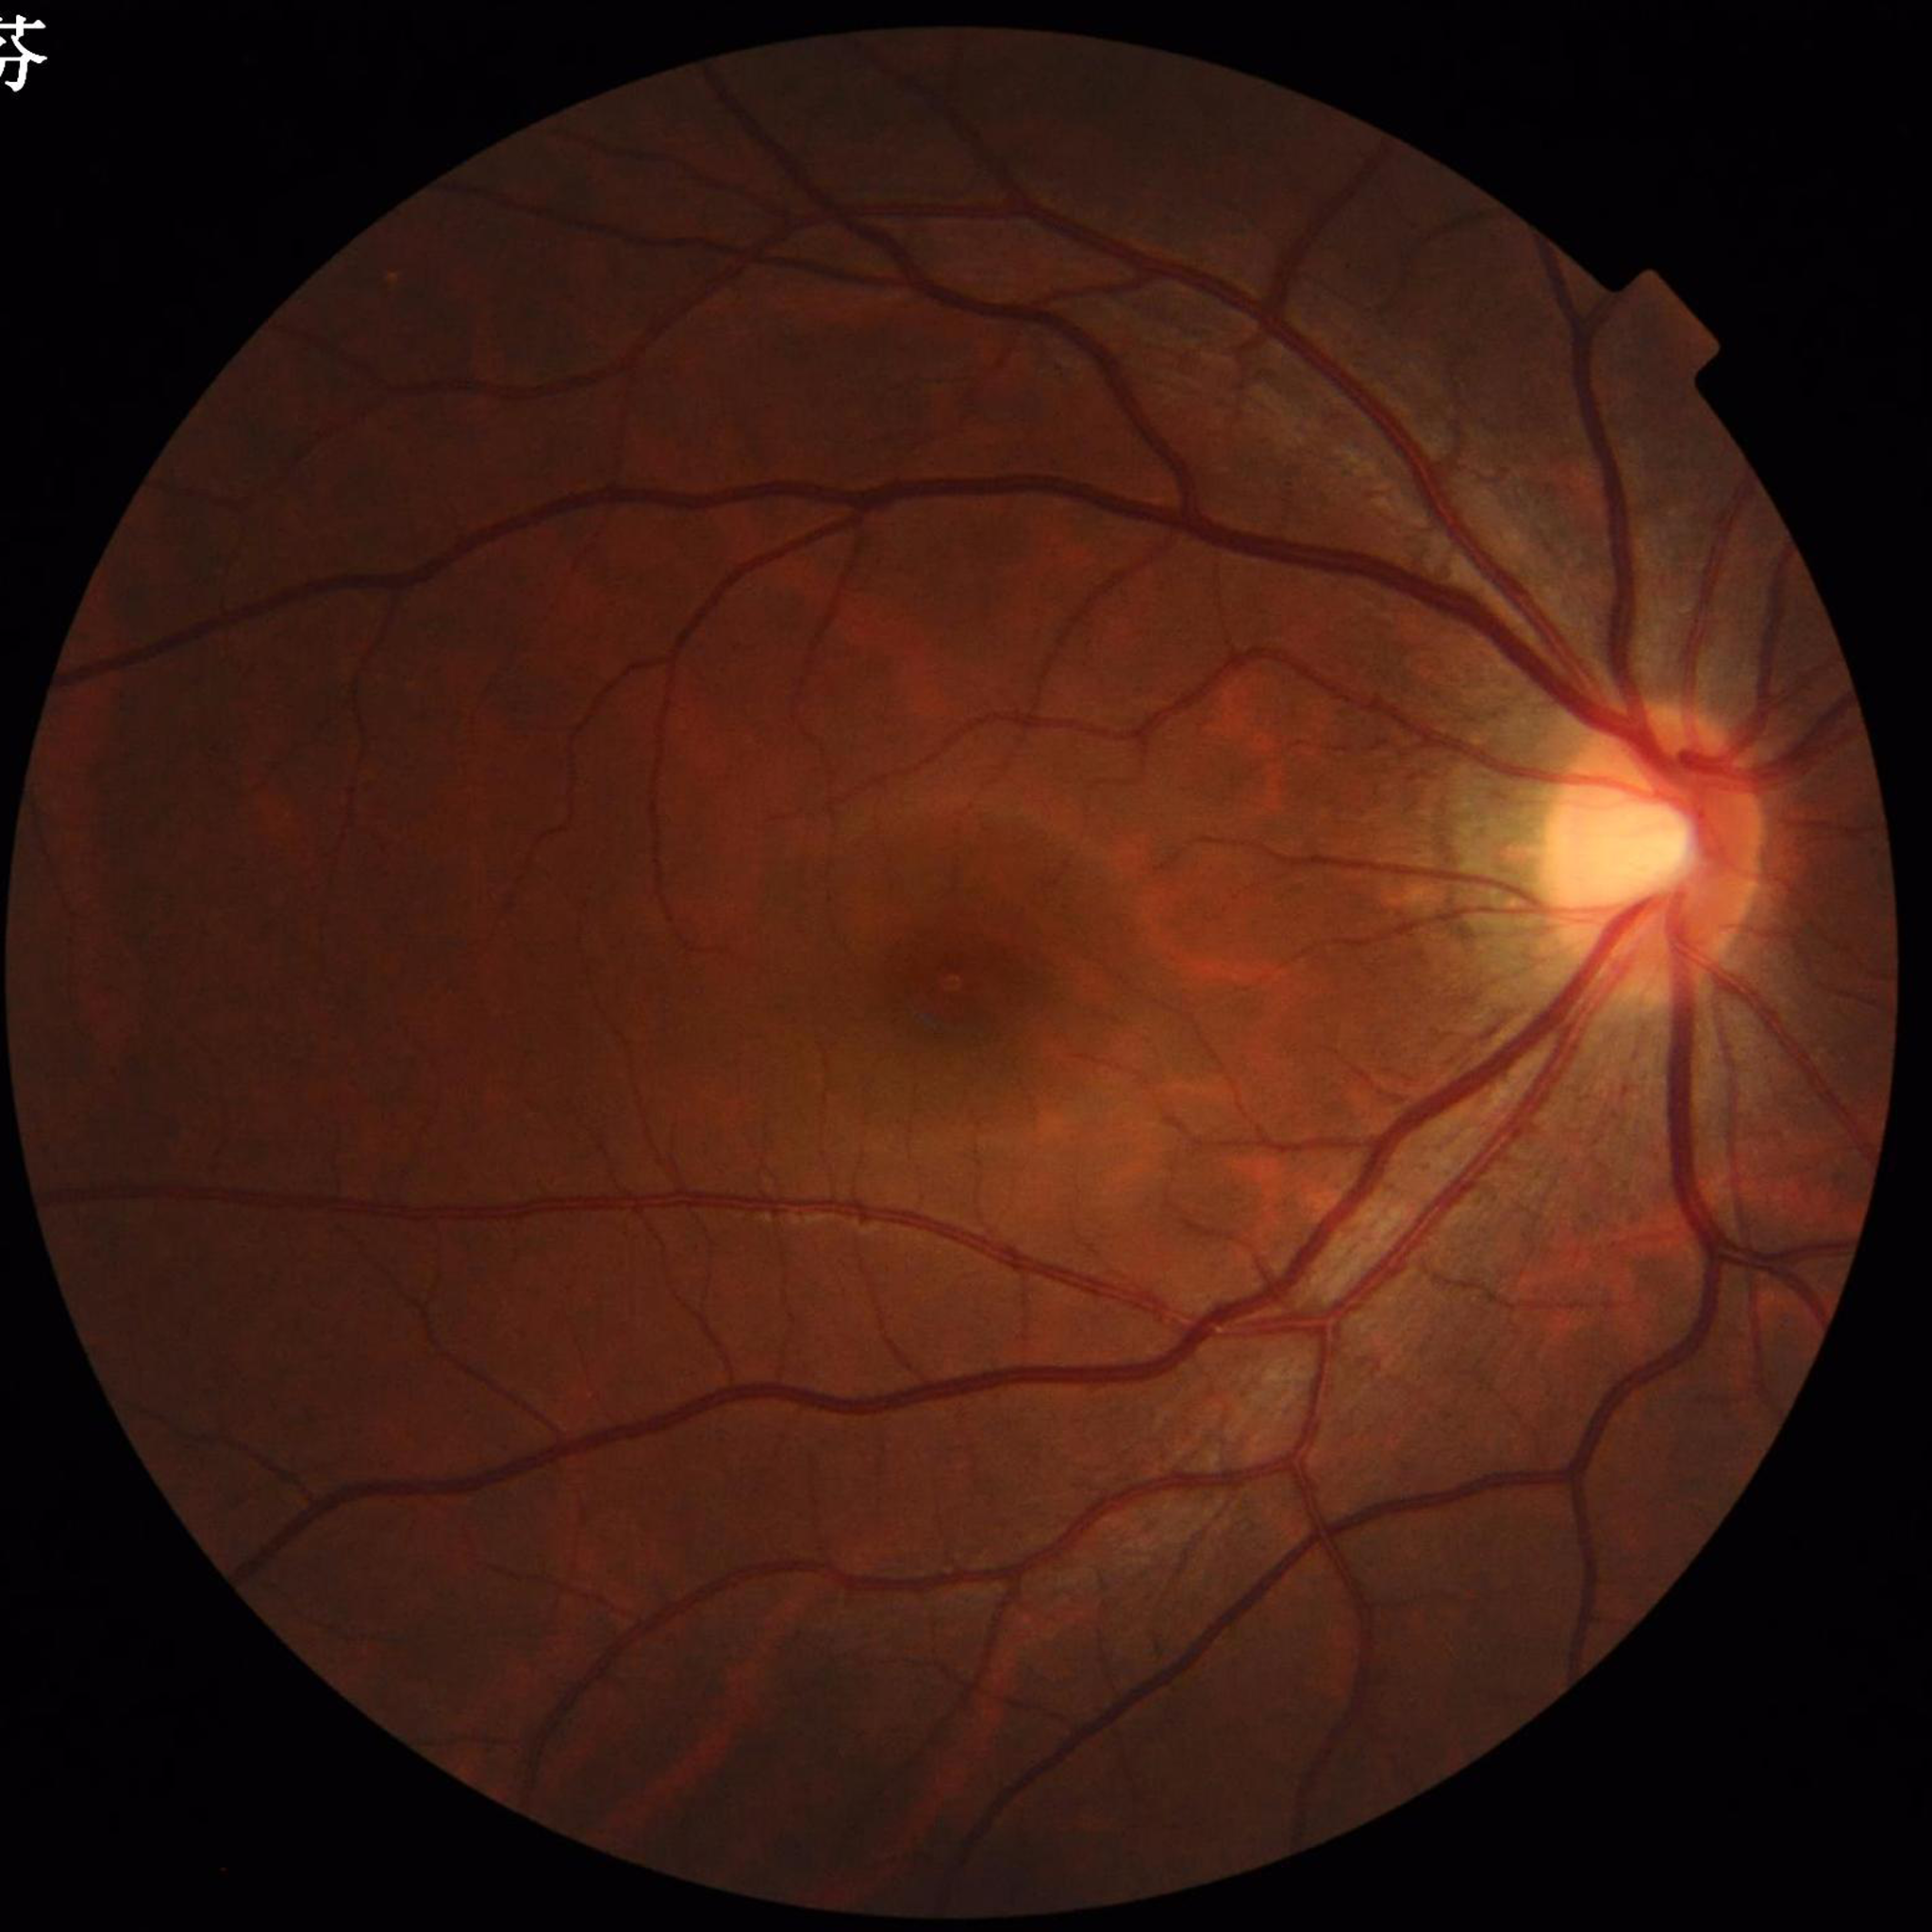
Photo quality: good. Color fundus photograph with no signs of AMD, diabetic retinopathy, or glaucoma.